60° field of view · portable fundus photograph.
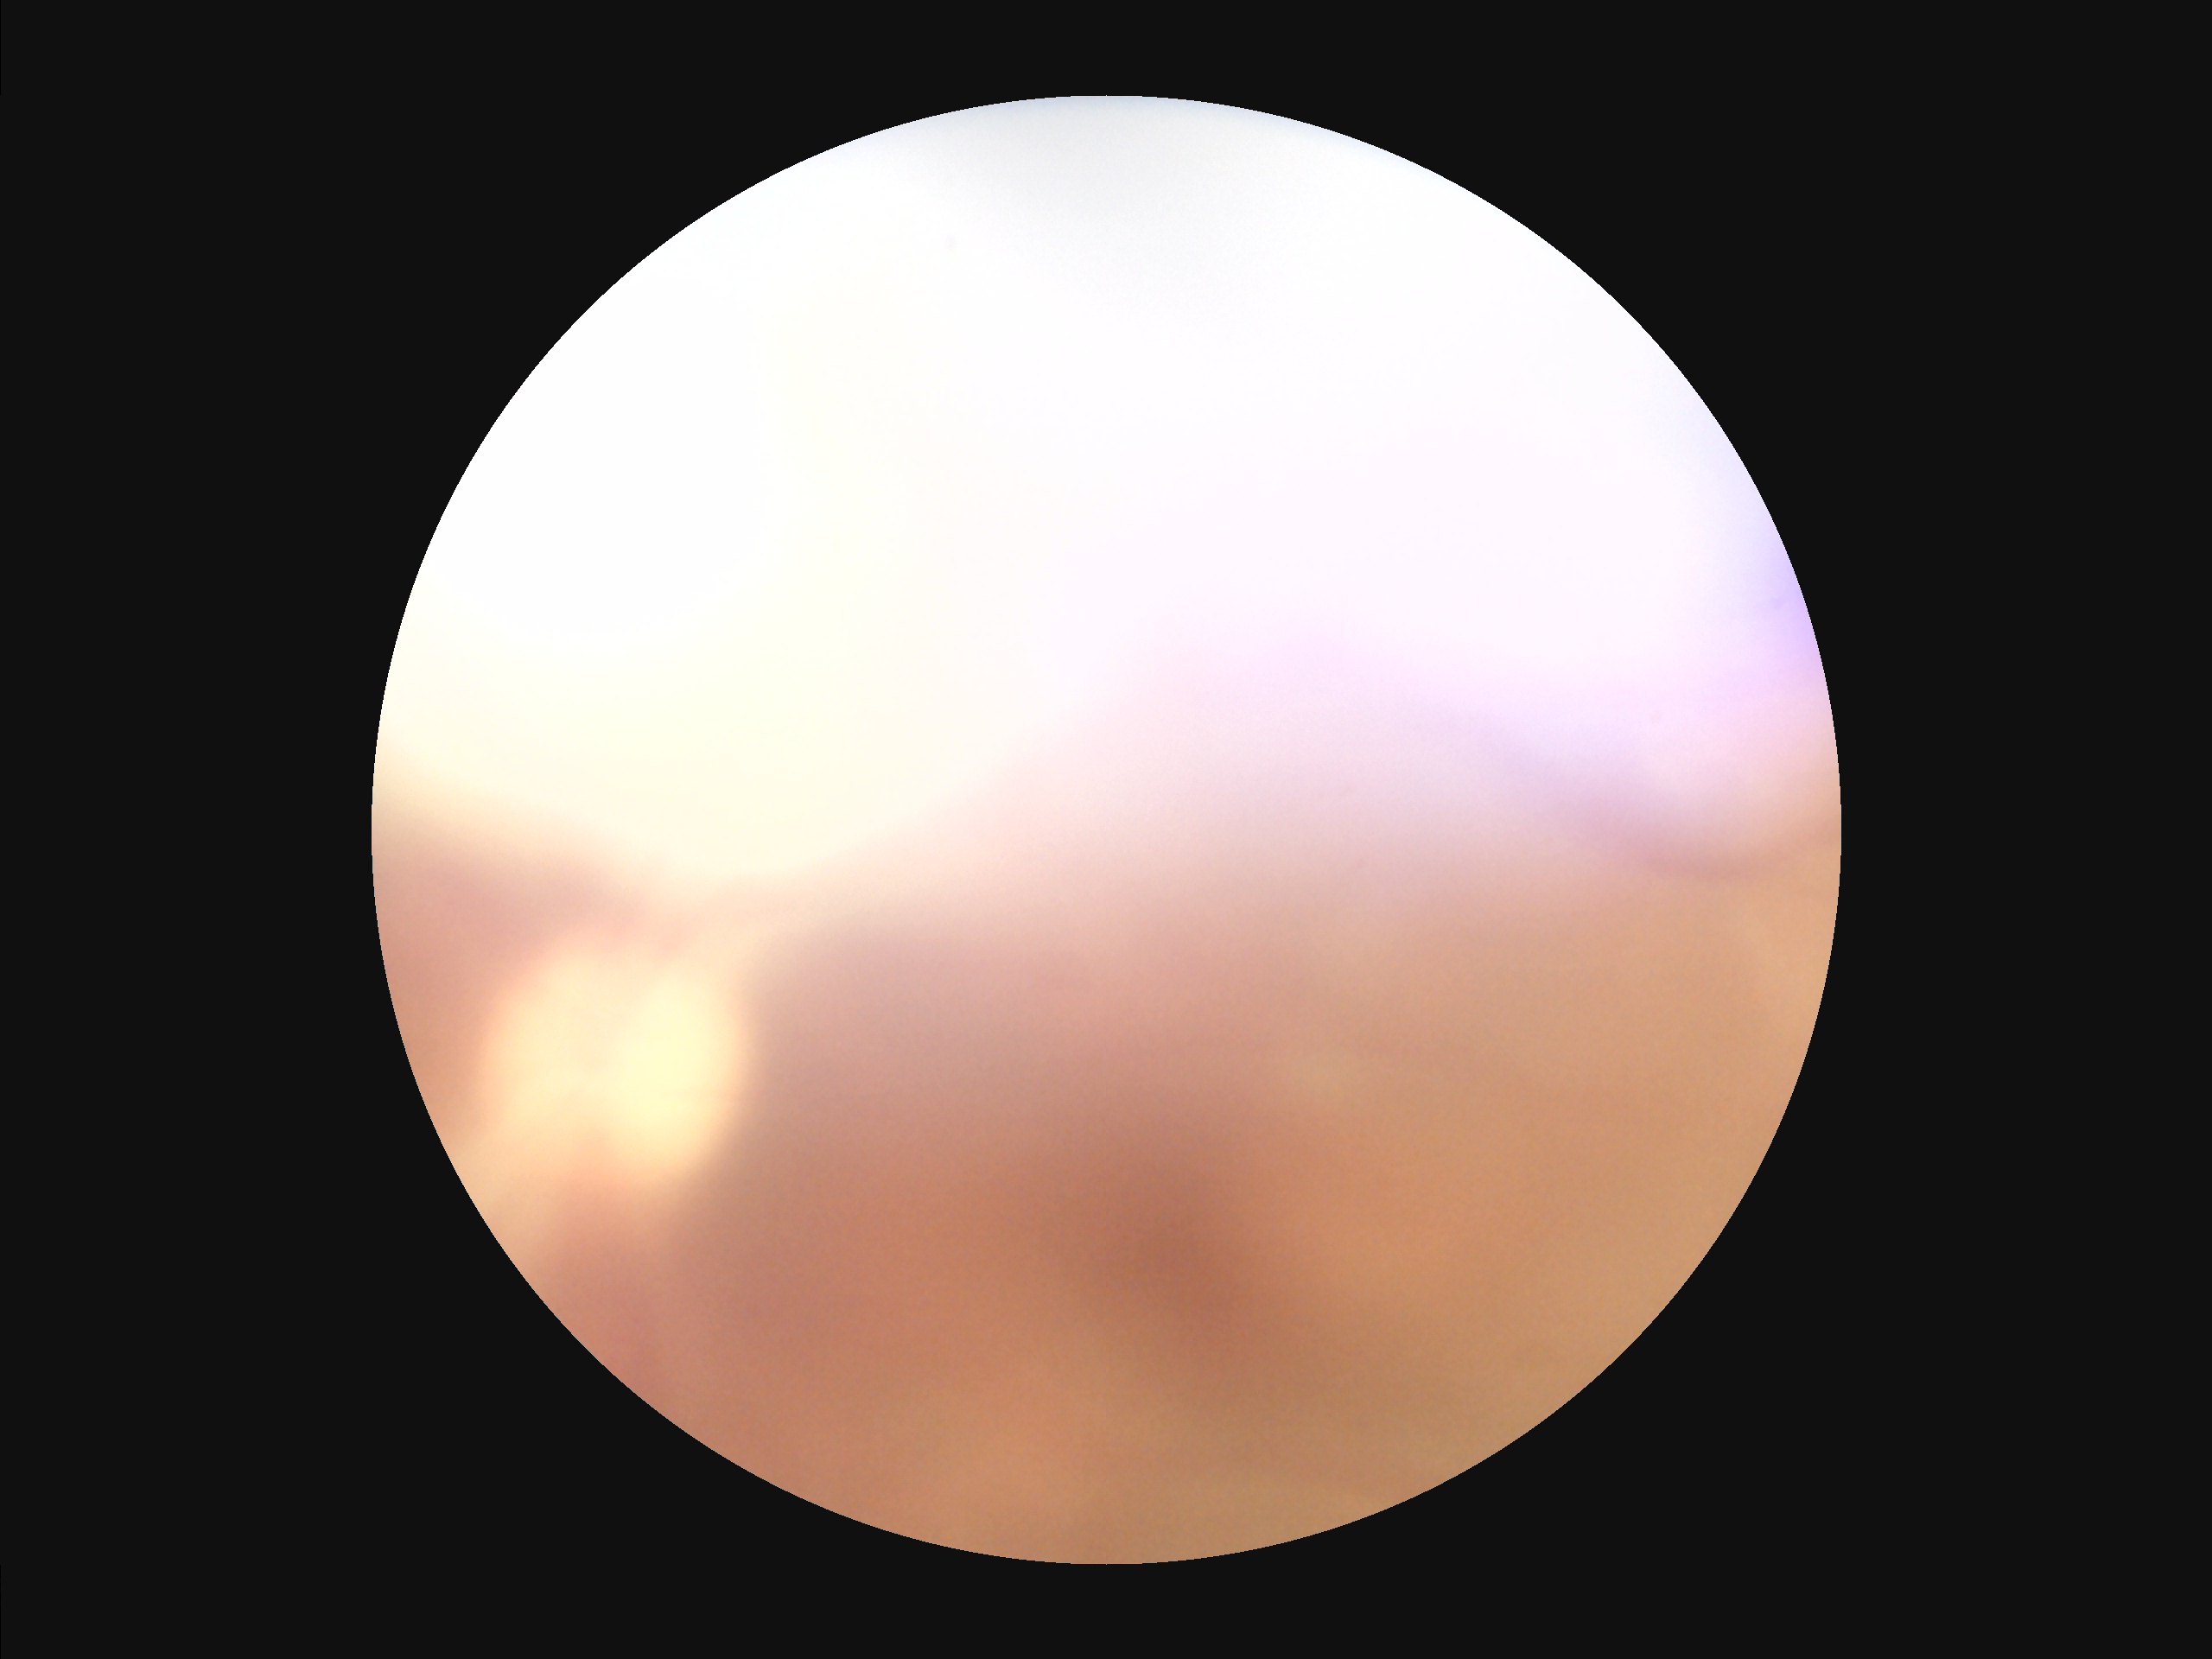
There is over- or under-exposure or a color cast. Image quality is suboptimal. Vessels and details are hard to distinguish. Reduced sharpness with visible blur.